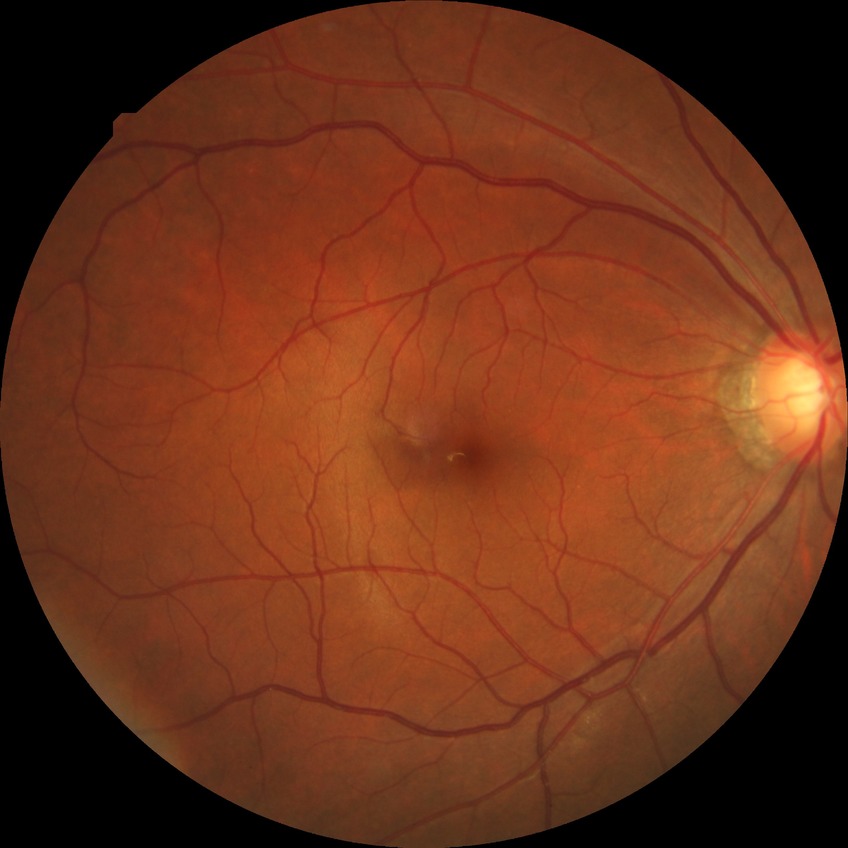
Annotations:
* diabetic retinopathy (DR): no diabetic retinopathy (NDR)